Wide-field fundus photograph of an infant:
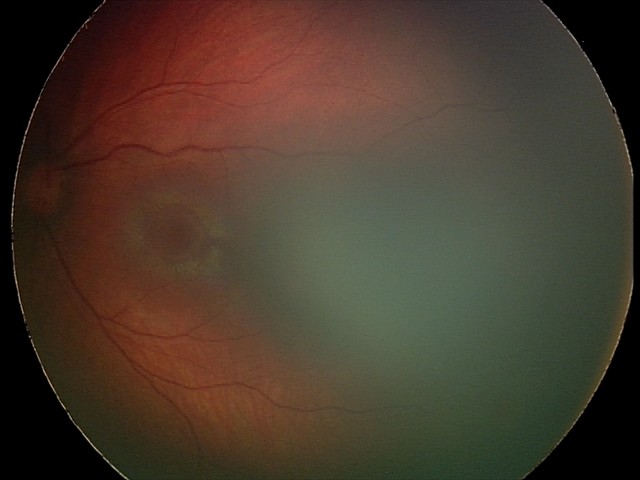
Examination diagnosed as retinal hemorrhages.